45-degree field of view. Color fundus image
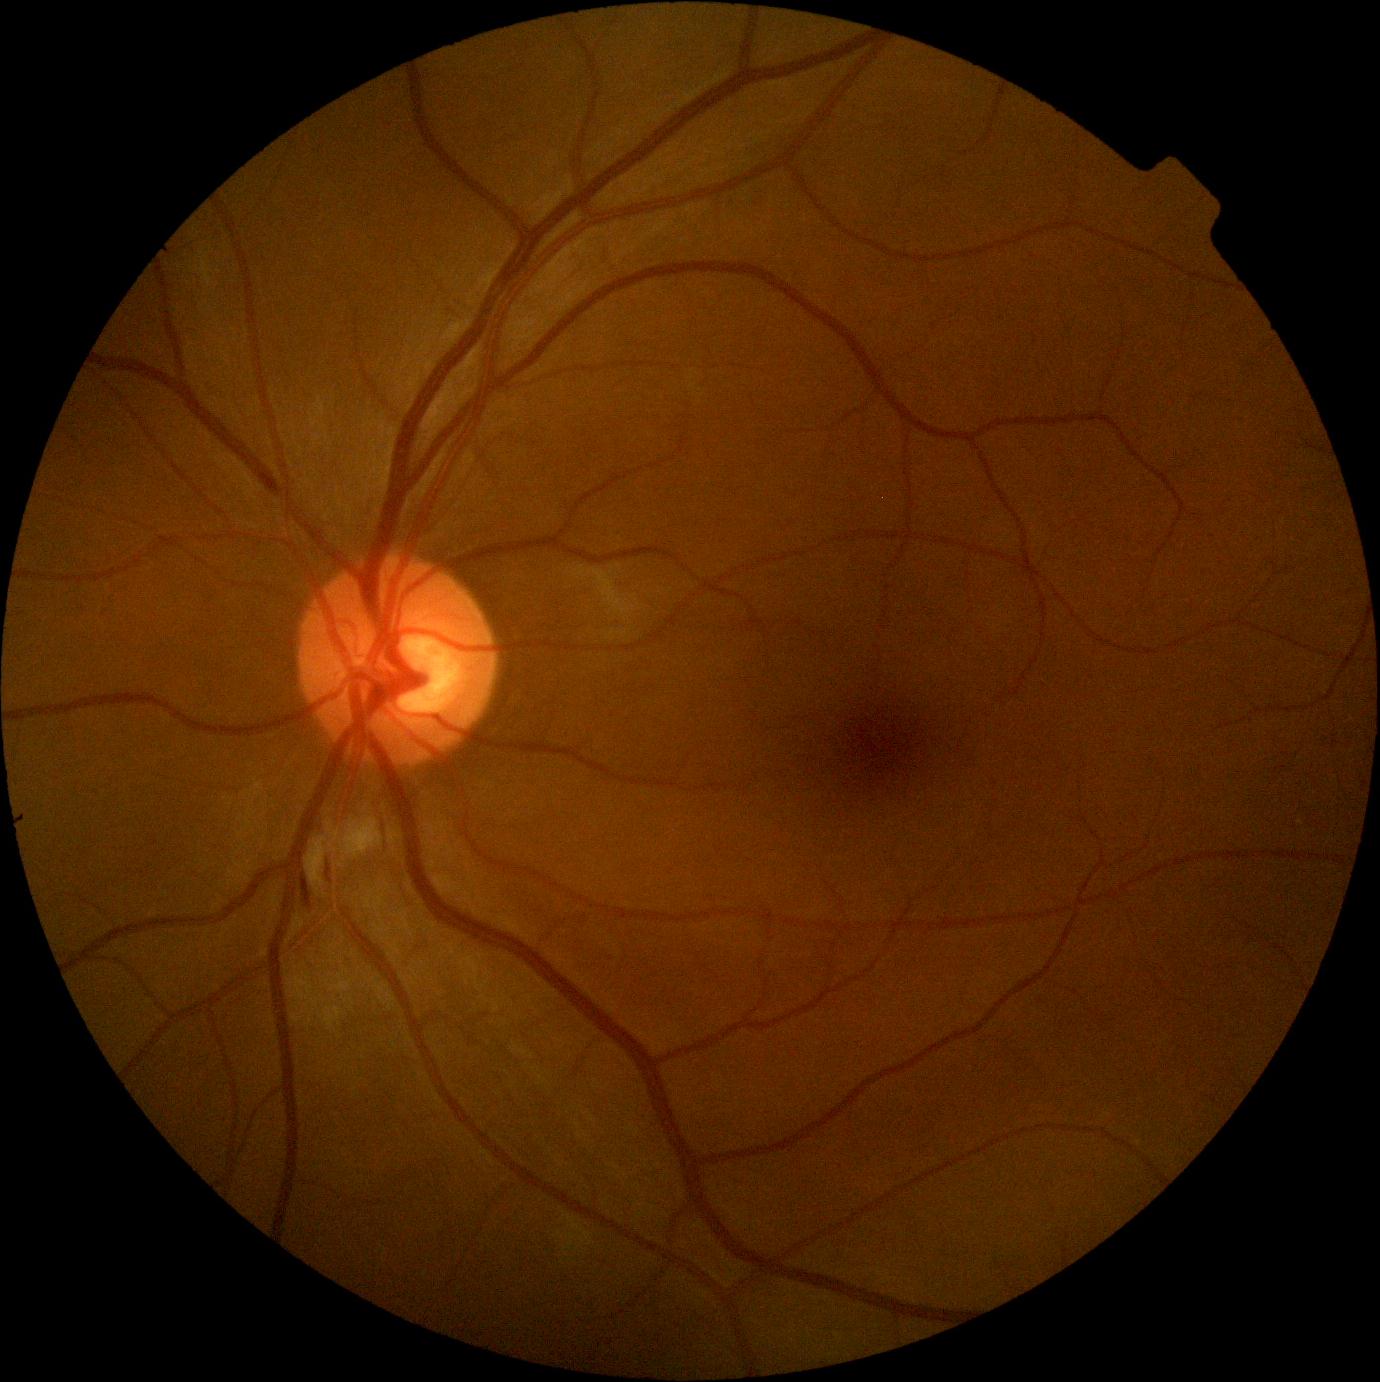 DR stage: grade 2 (moderate NPDR). The retinopathy is classified as non-proliferative diabetic retinopathy.